Wide-field fundus photograph of an infant; 640 x 480 pixels — 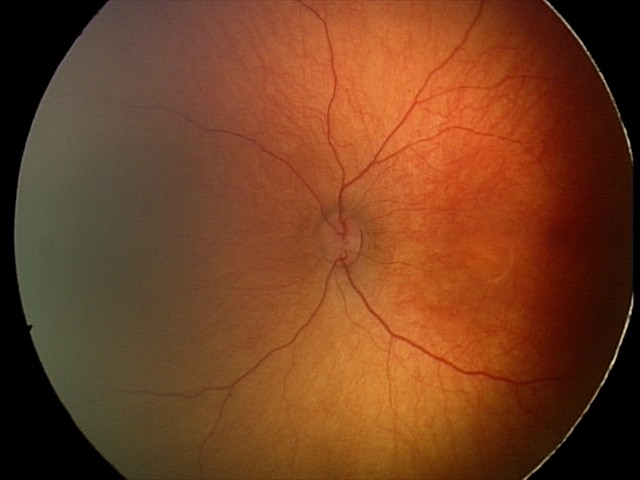
Screening examination diagnosed as physiological.